45° field of view · 2048 by 1536 pixels:
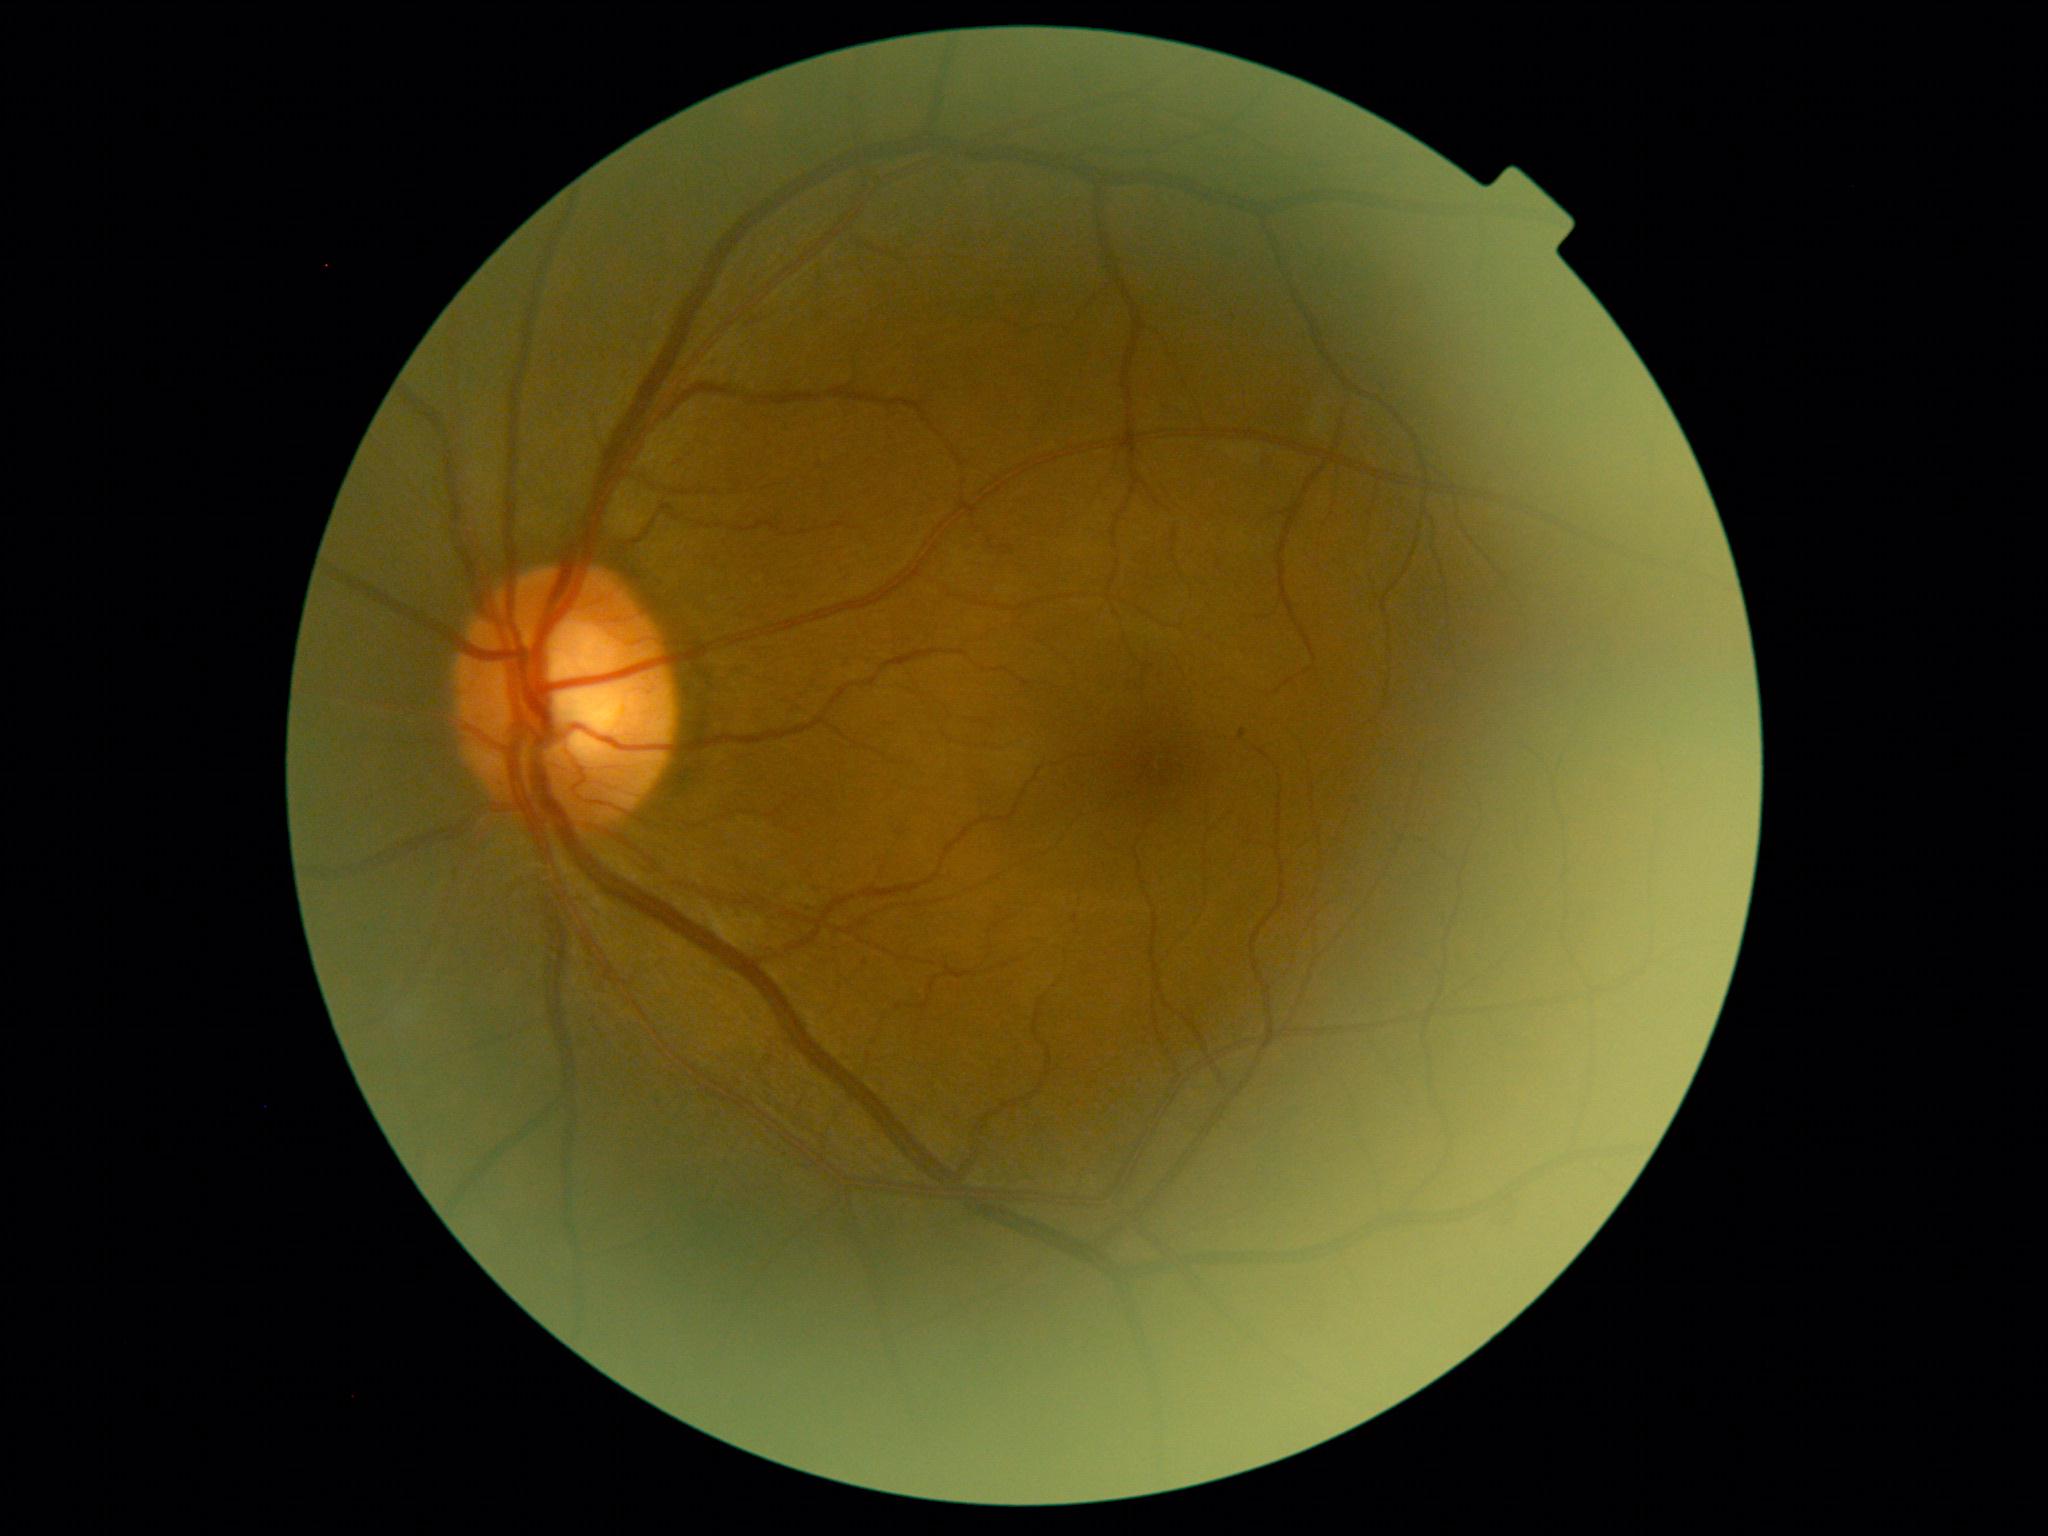
DR stage: 1/4 — presence of microaneurysms only. Disease class: non-proliferative diabetic retinopathy.